FOV: 50 degrees. Color fundus image. Acquired with a Kowa VX-10α. 2361 by 1568 pixels. Dilated-pupil acquisition. Macula-centered — 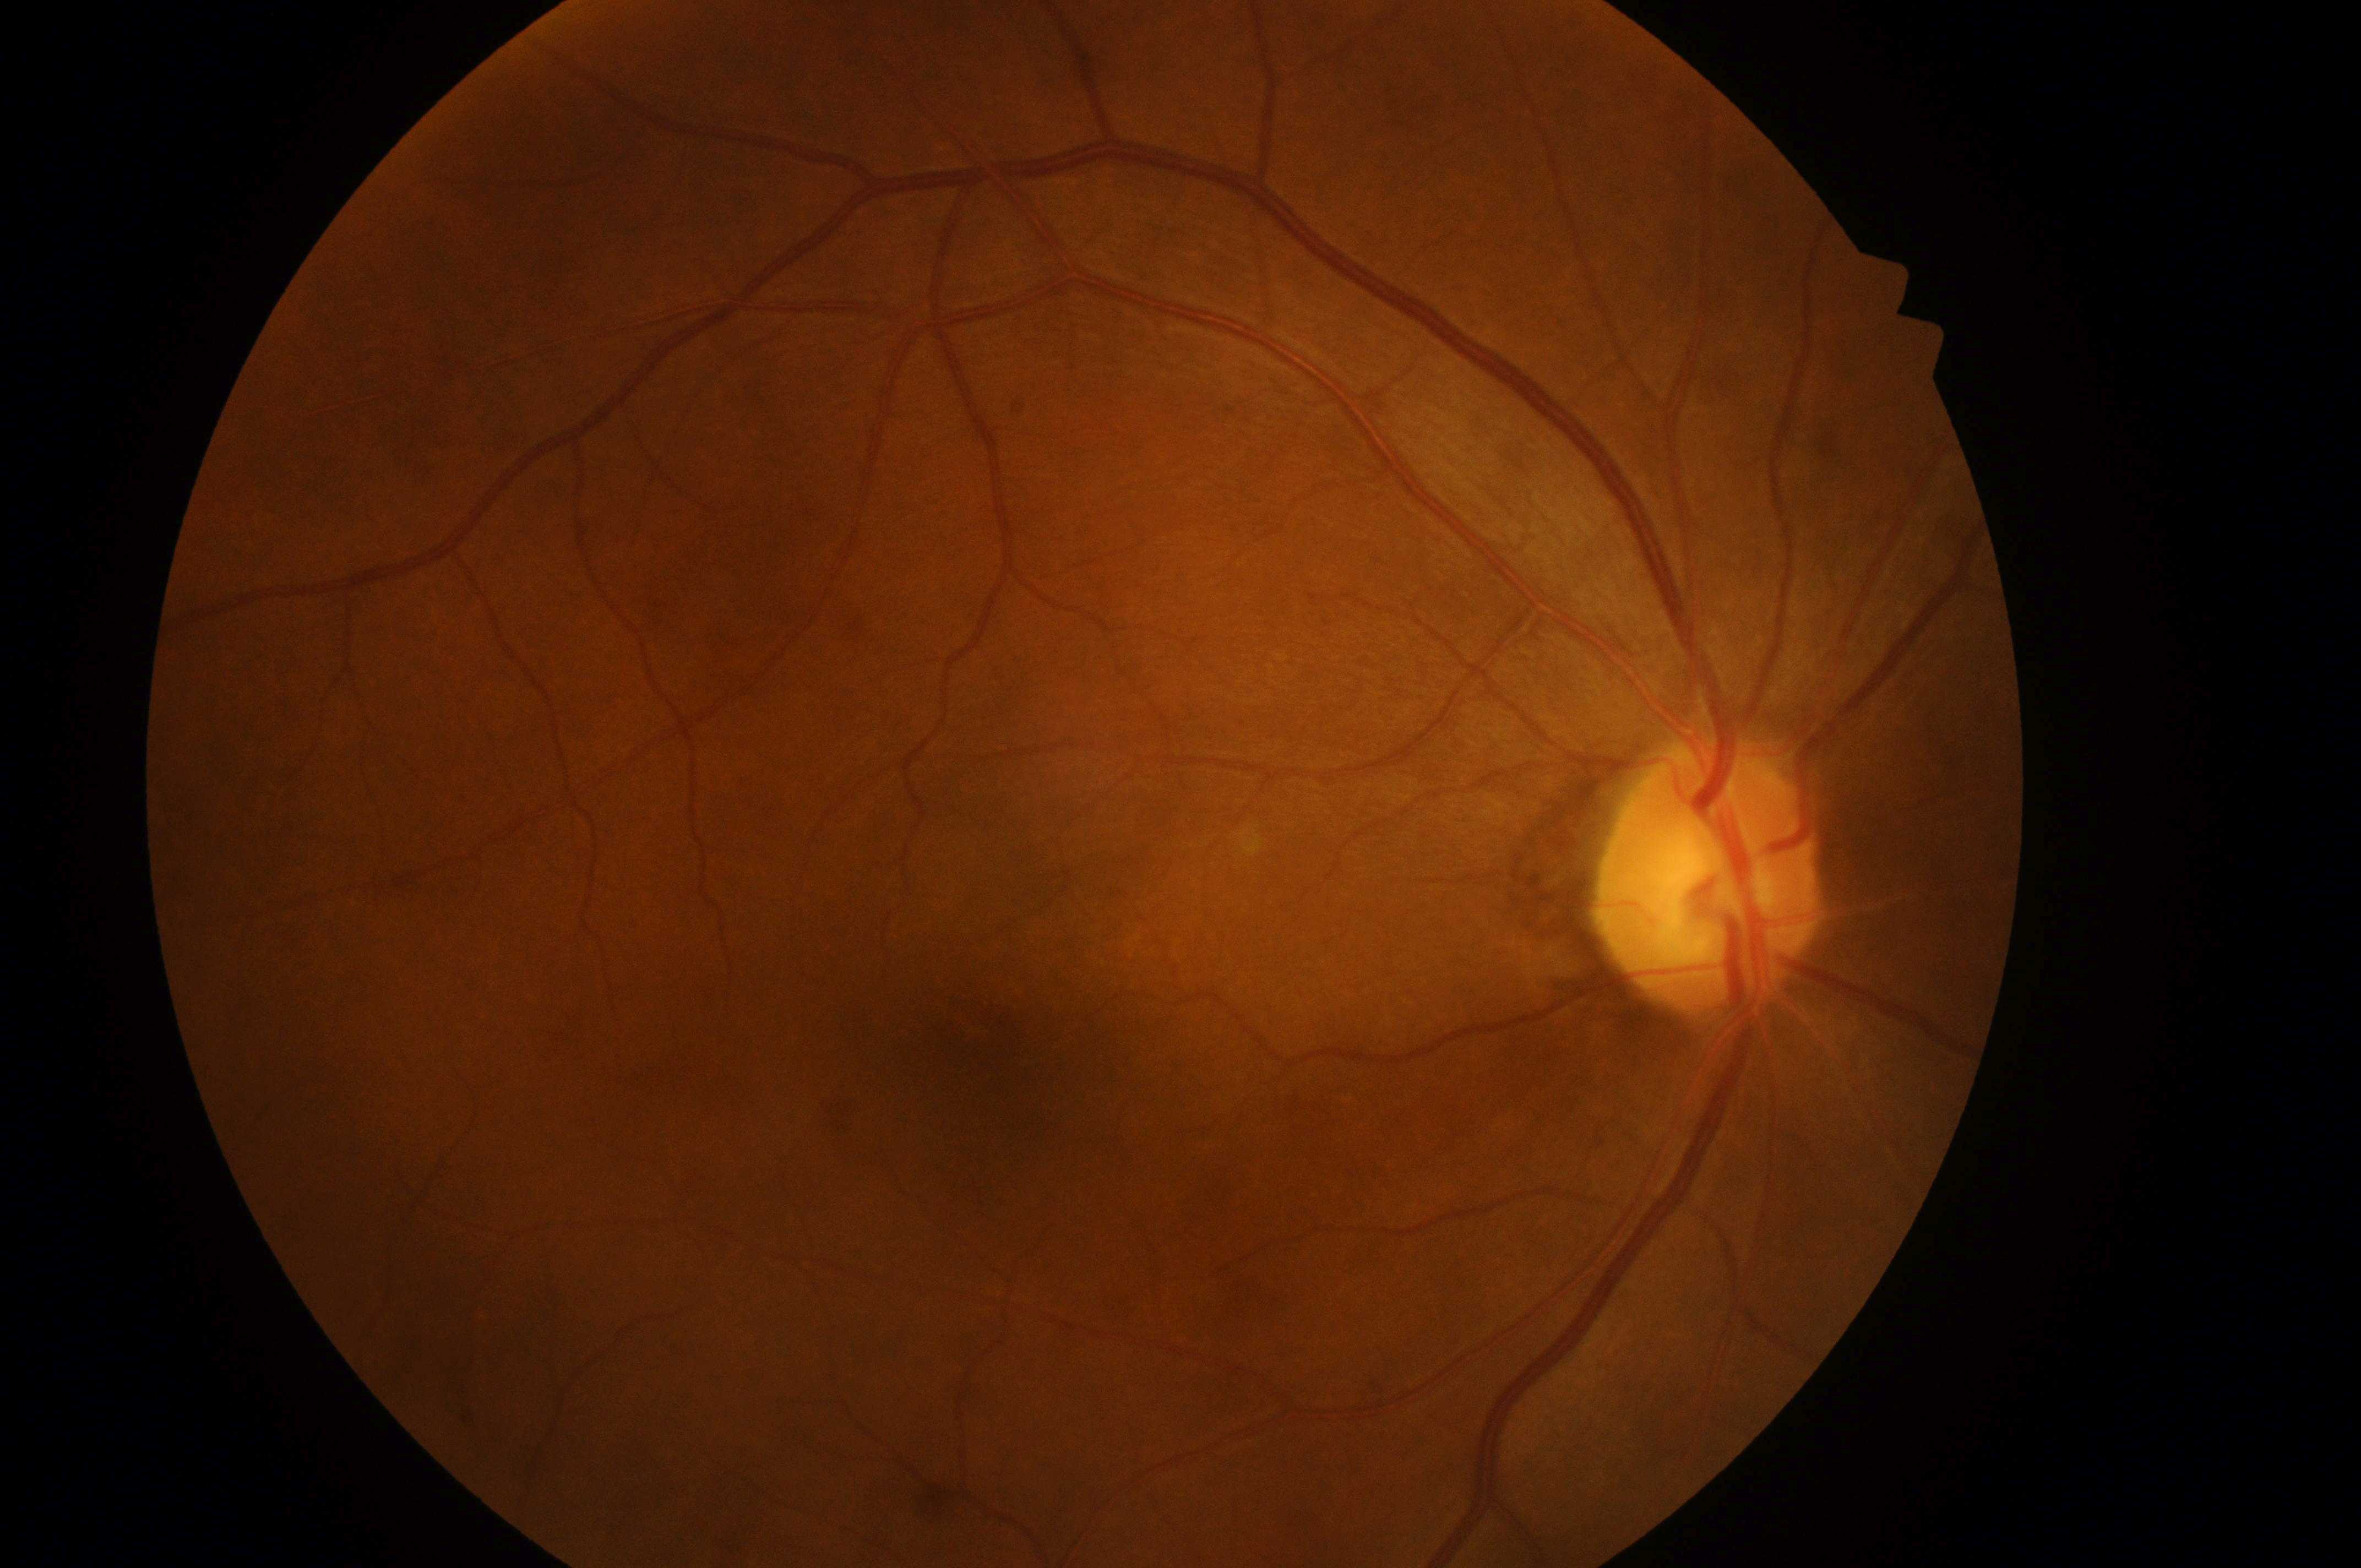

optic disk: (x: 1708, y: 890)
retinopathy grade: 0 (no apparent retinopathy)
risk of diabetic macular edema: no risk (grade 0)
DR impression: No diabetic retinal disease findings
laterality: right
fovea center: (x: 1004, y: 1086)